1659x2212:
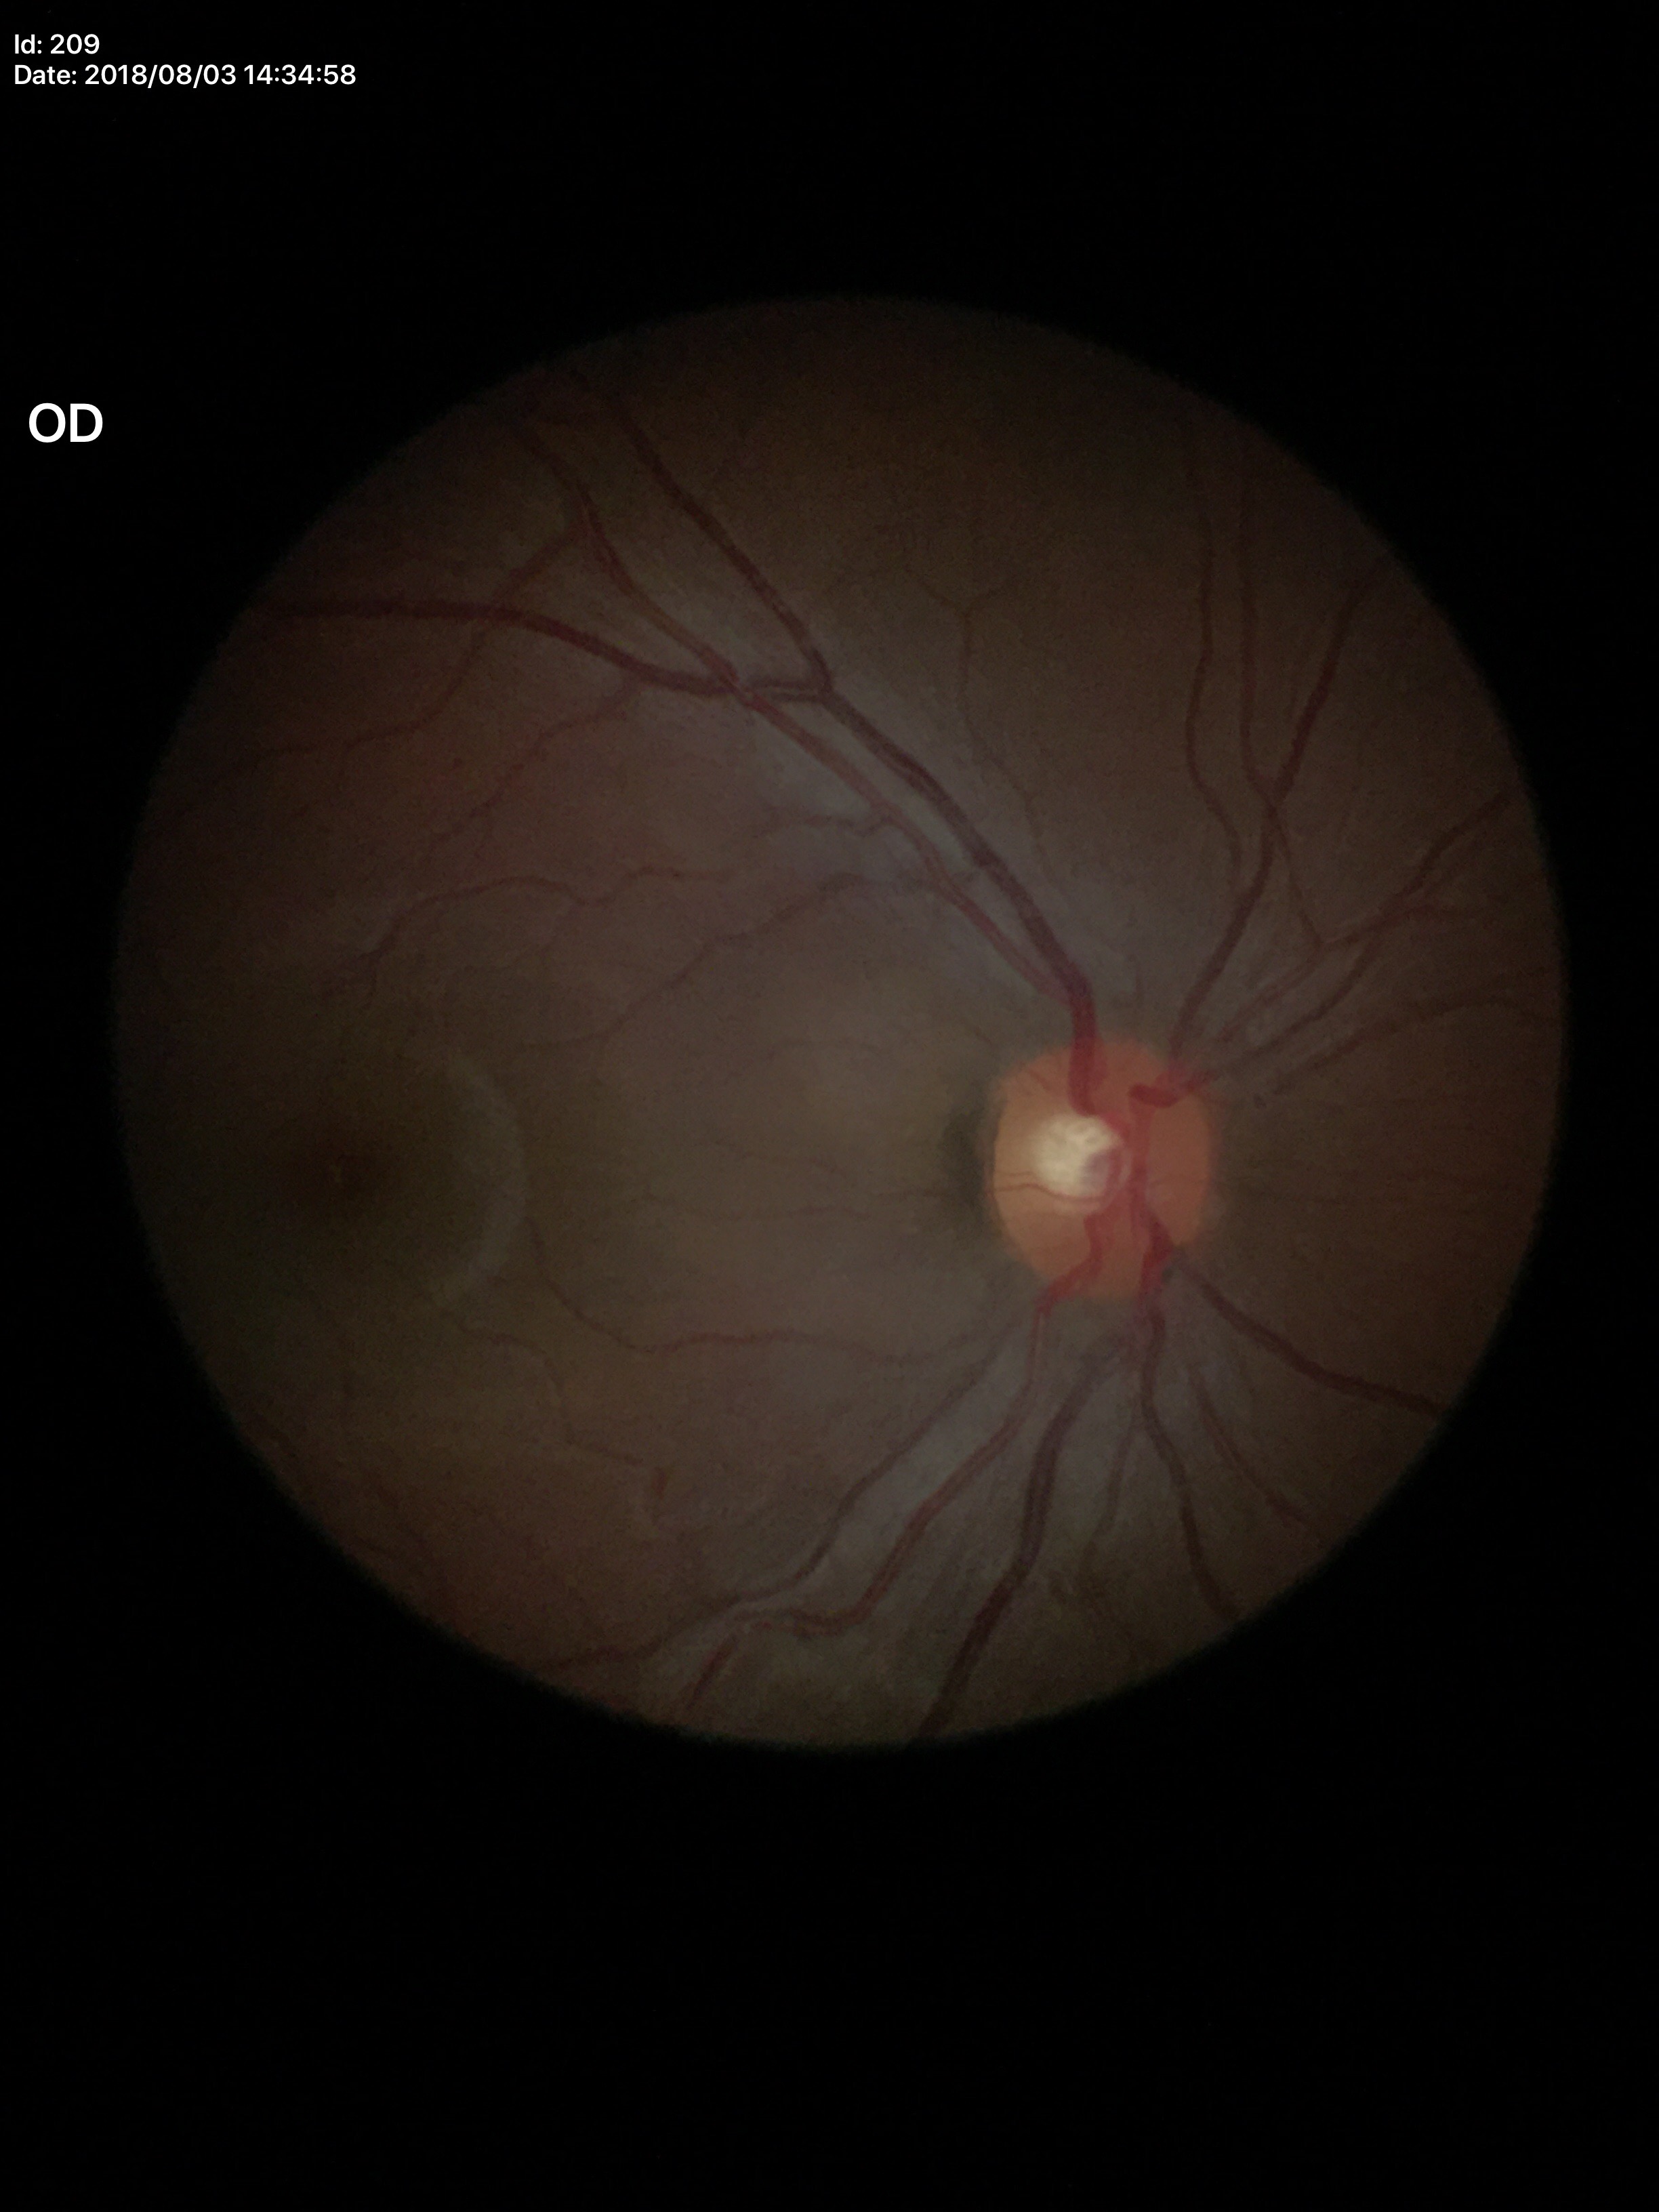
vertical CDR: 0.43, Glaucoma impression: negative.